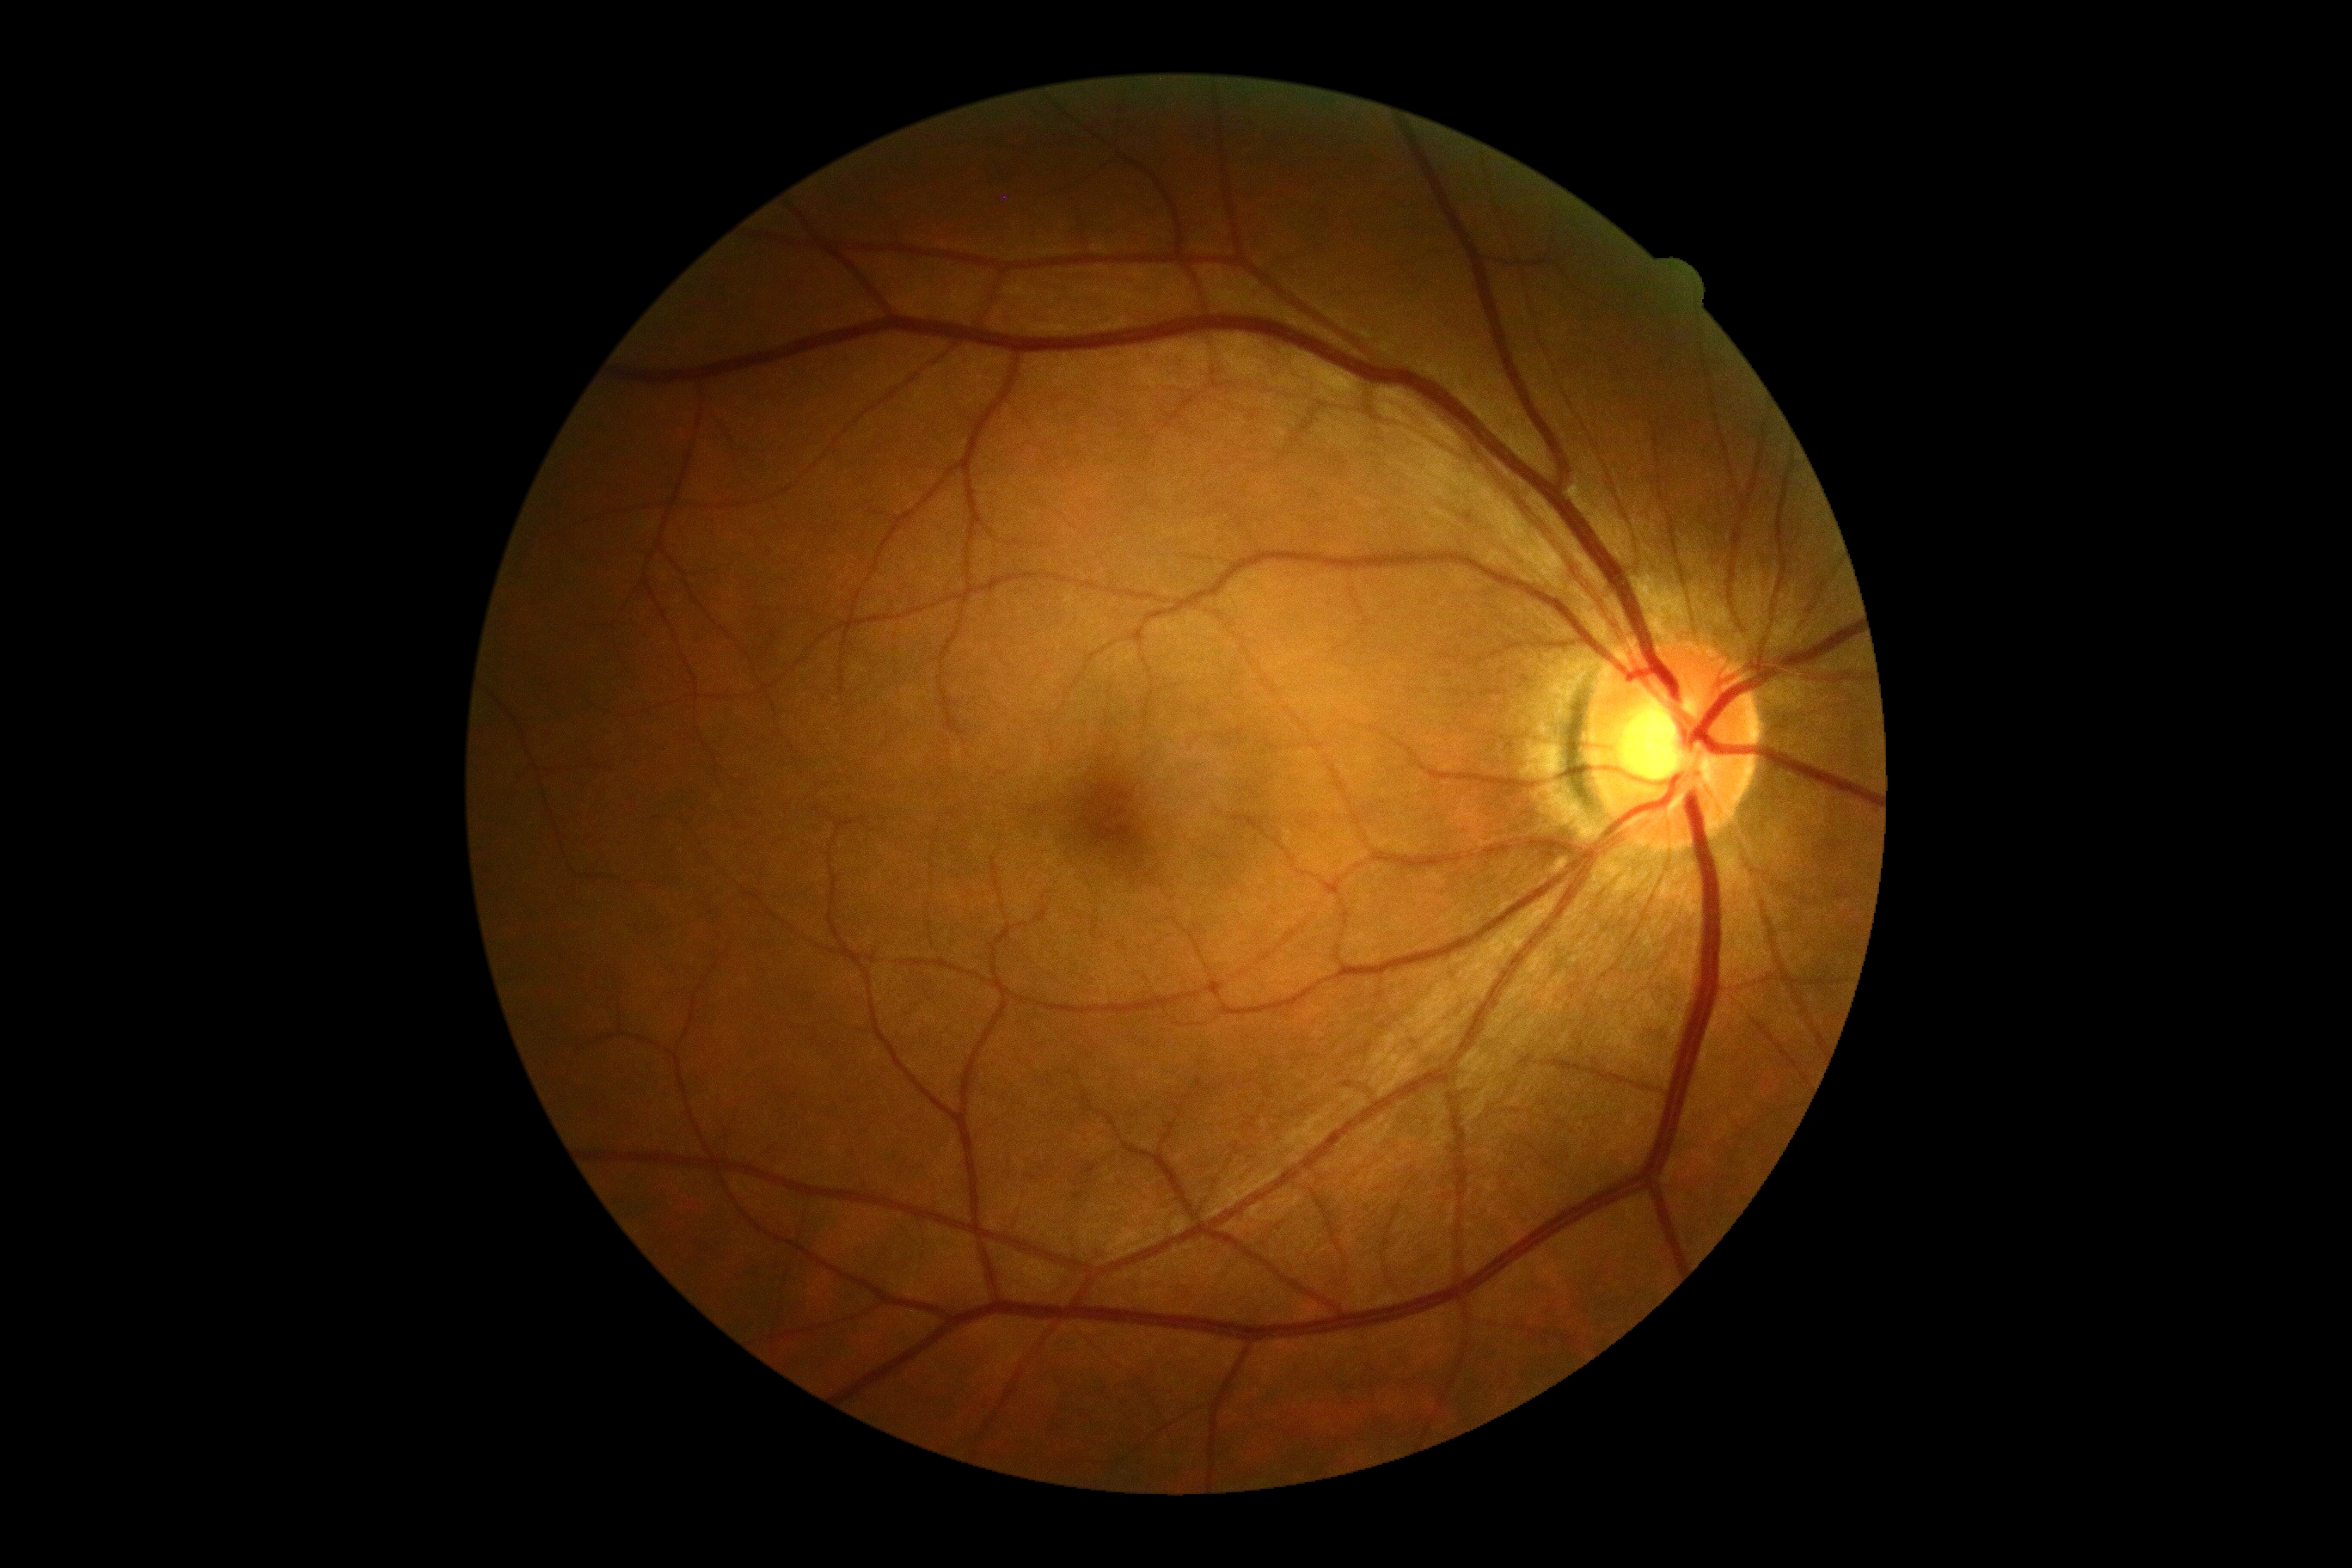 No apparent diabetic retinopathy. Diabetic retinopathy (DR): no apparent diabetic retinopathy (grade 0).